Pediatric retinal photograph (wide-field) · 640 by 480 pixels: 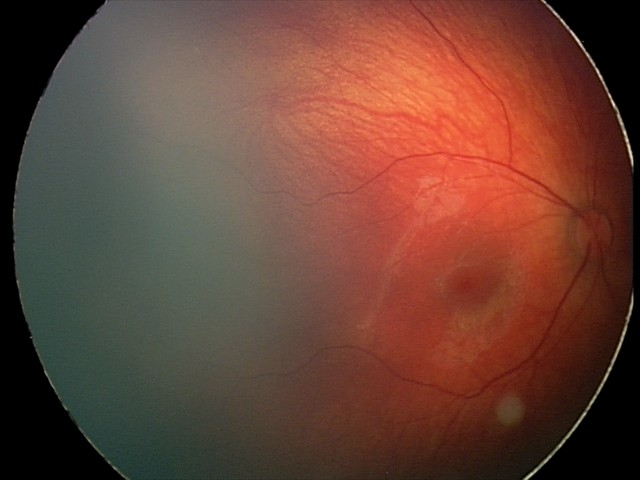 Q: What is the screening diagnosis?
A: retinal hemorrhages